2352 x 1568 pixels, color fundus image
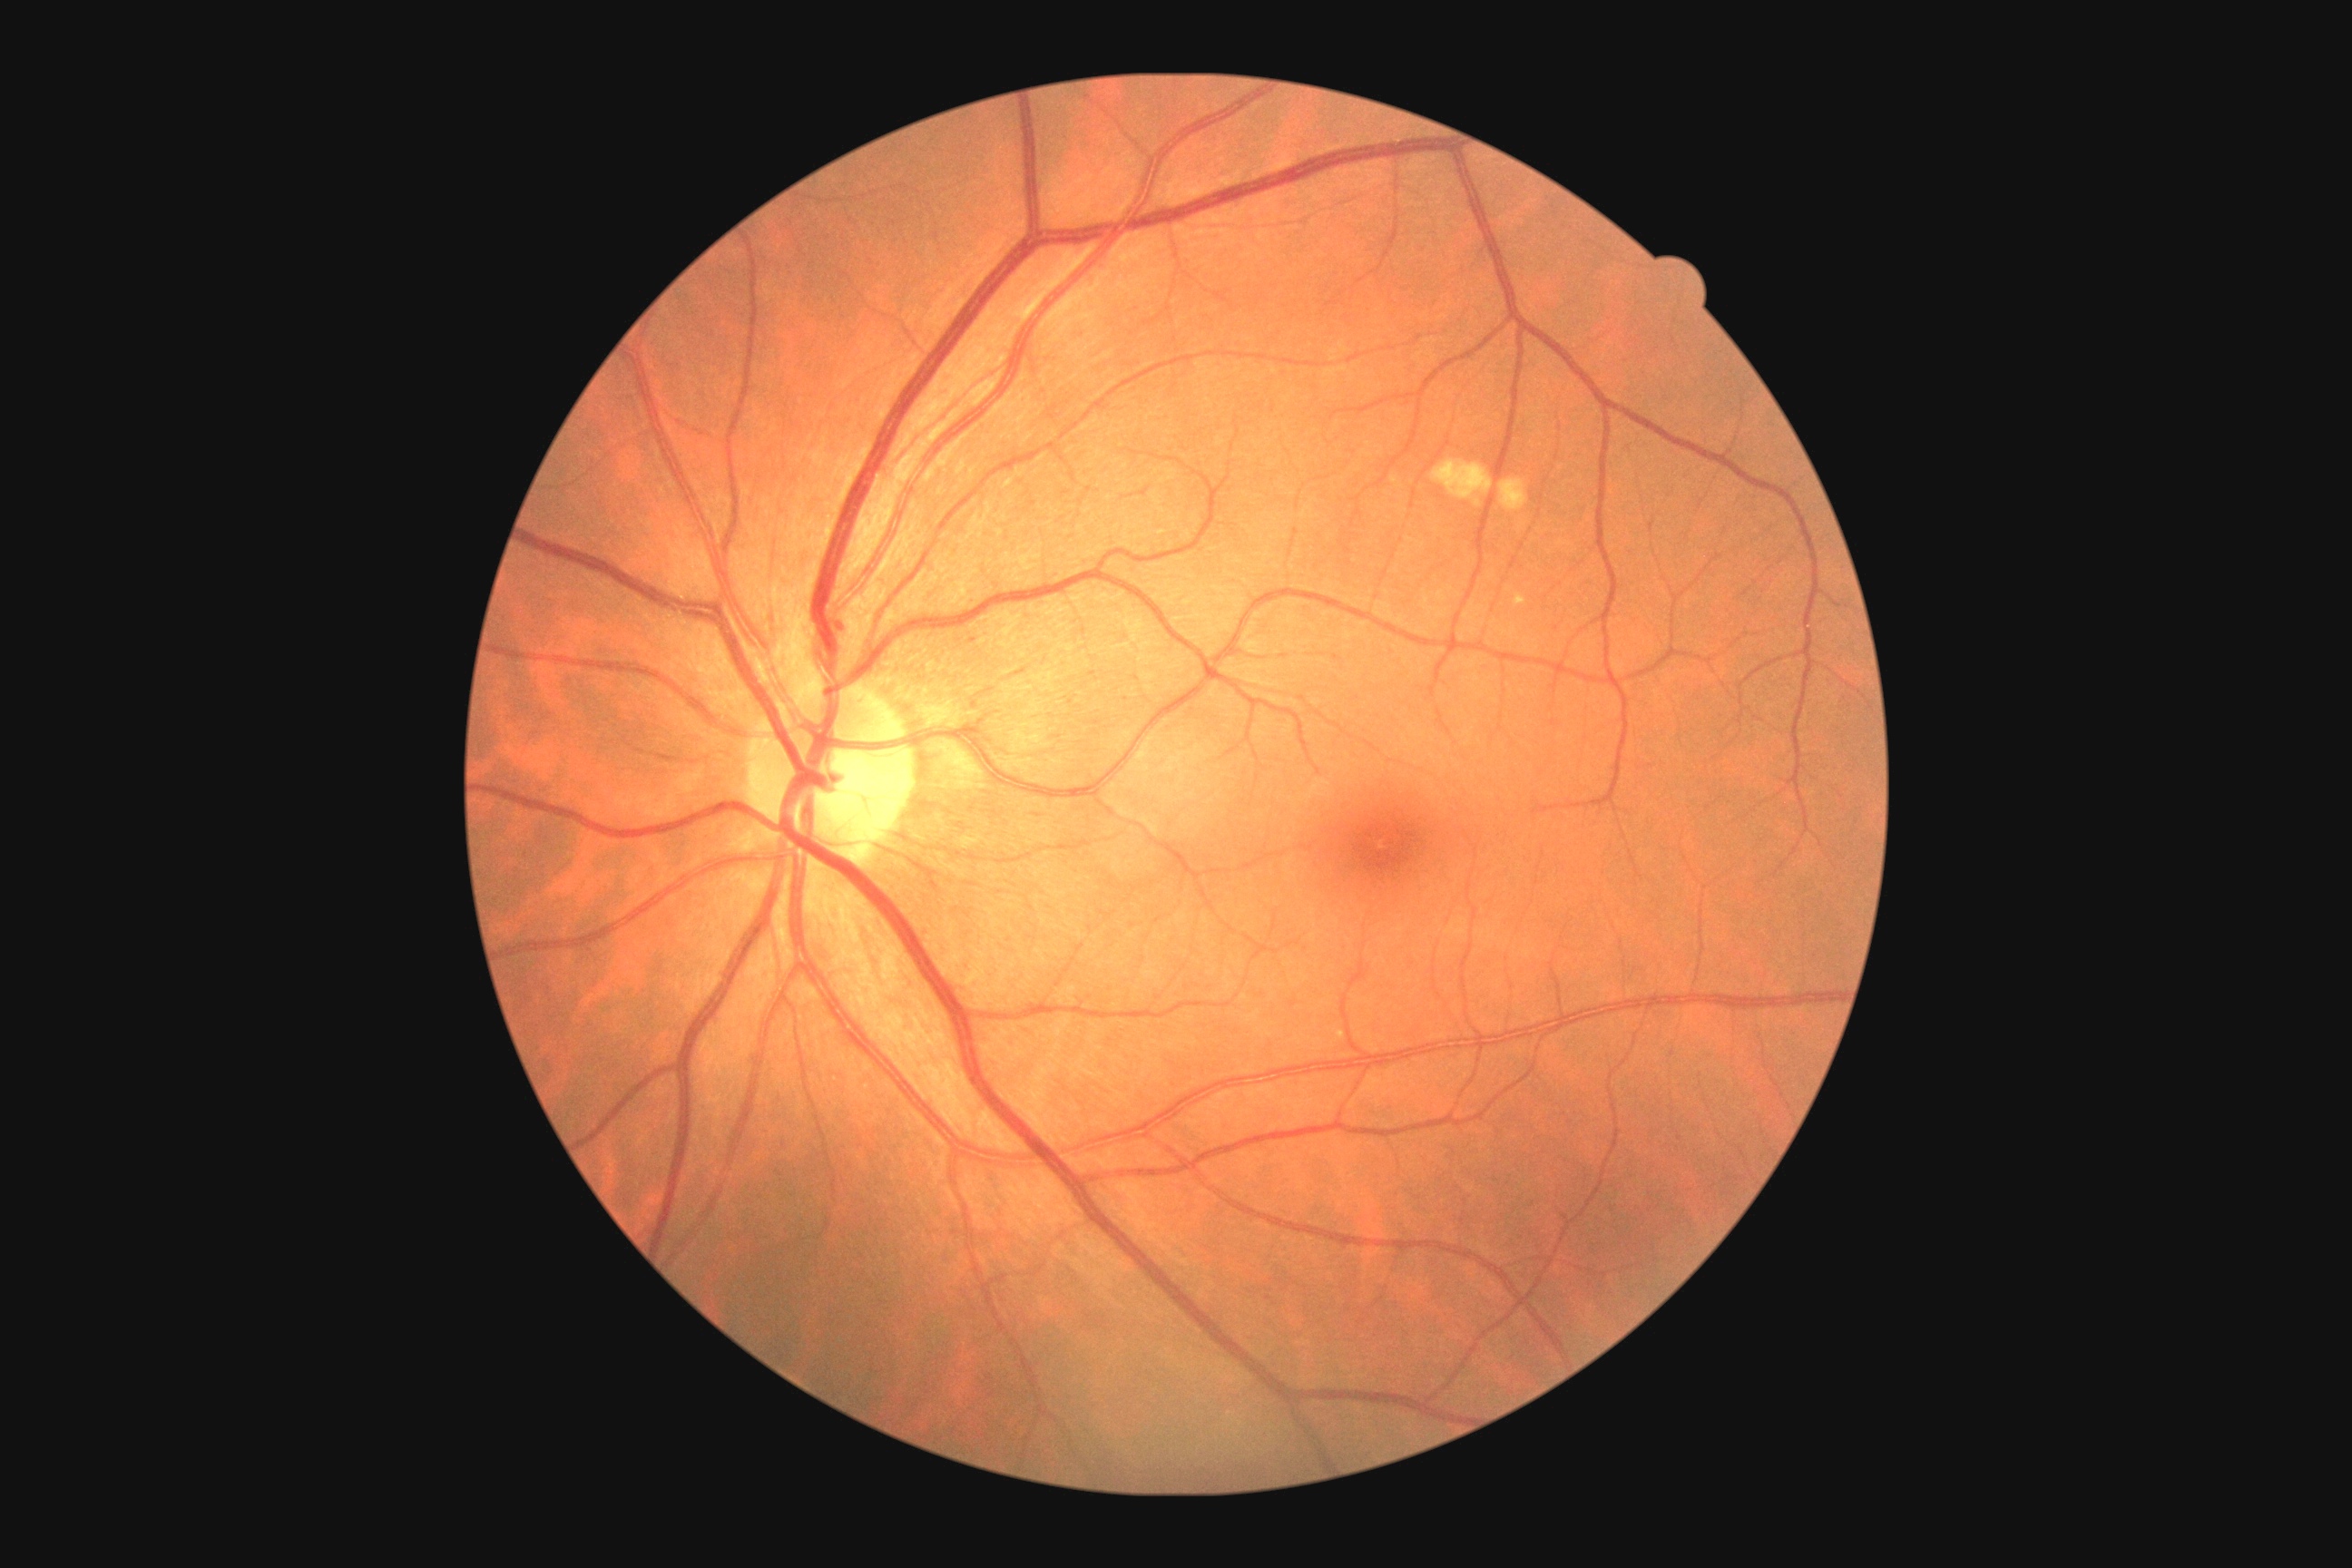
Disease class: non-proliferative diabetic retinopathy. Retinopathy grade: mild non-proliferative diabetic retinopathy (1).